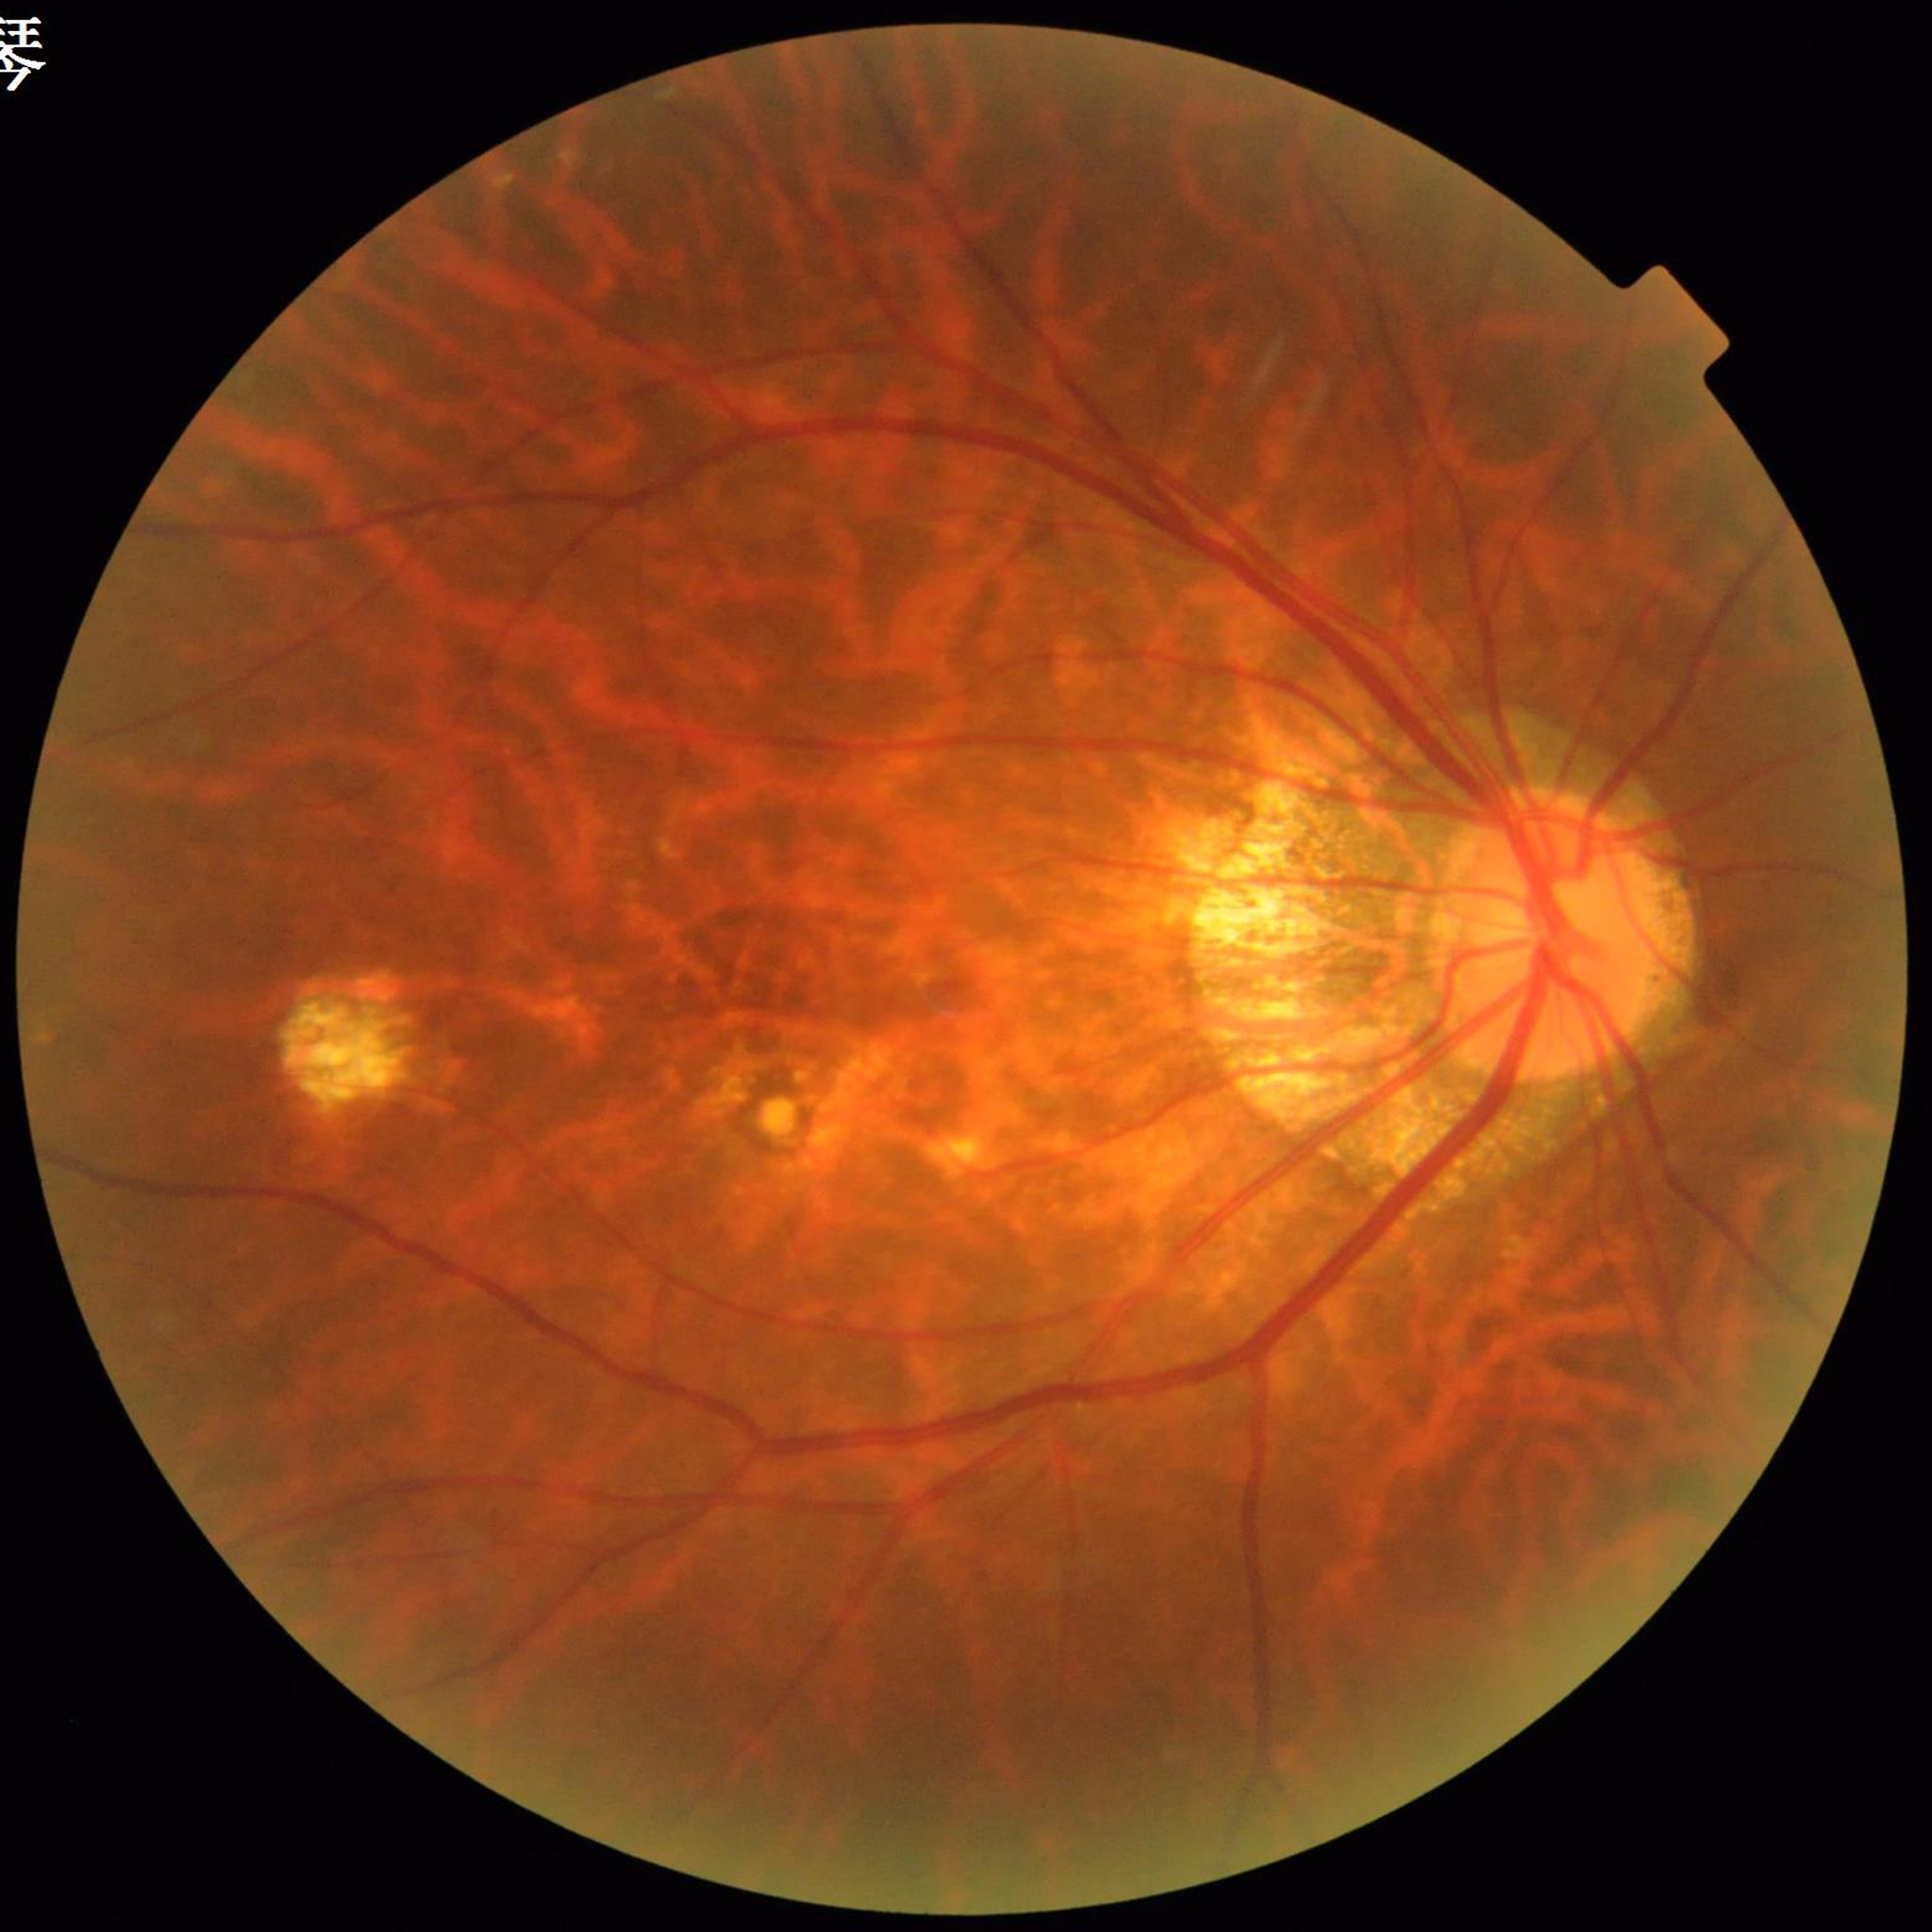 Impression = age-related macular degeneration